Modified Davis grading: 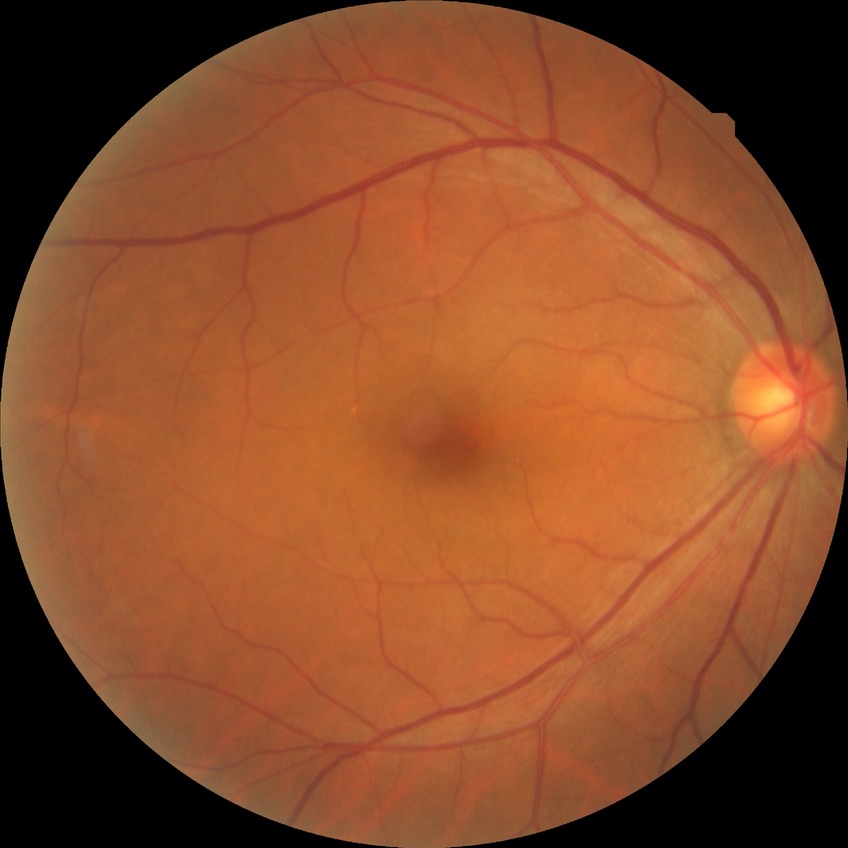 Annotations:
• diabetic retinopathy (DR) — no diabetic retinopathy (NDR)